2212x1659.
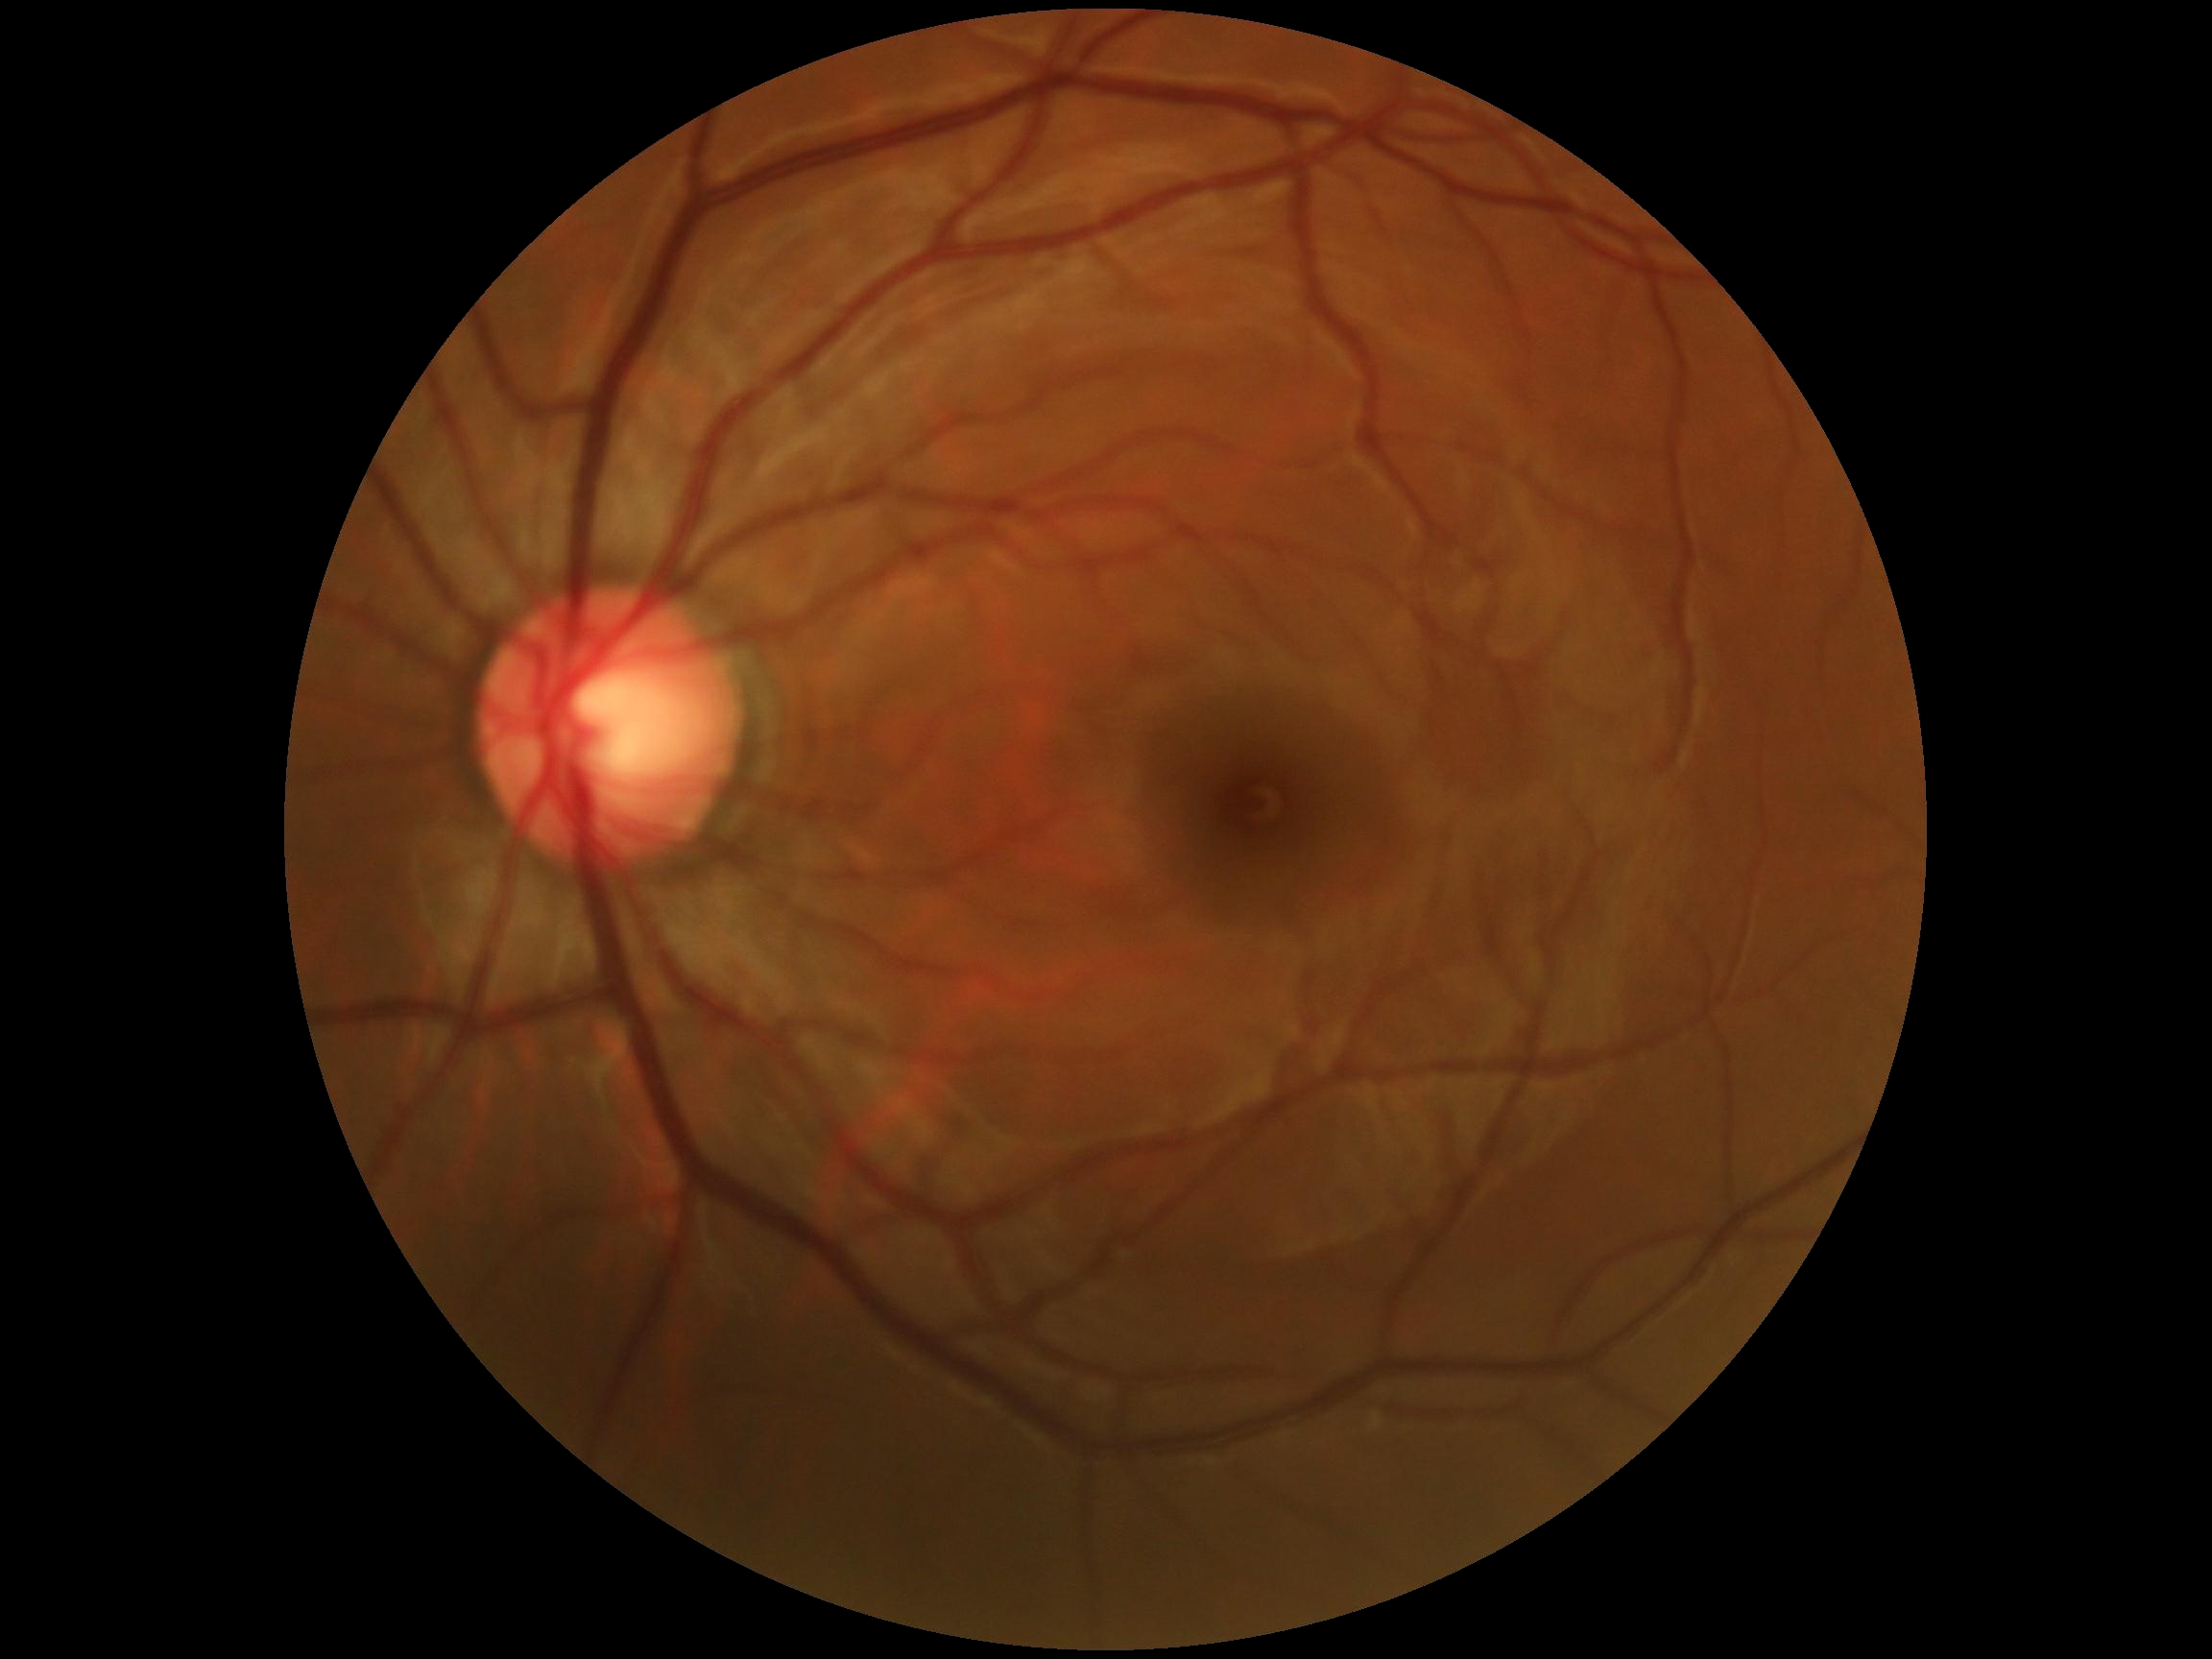
DR impression = no DR findings; DR stage = grade 0.